CFP — 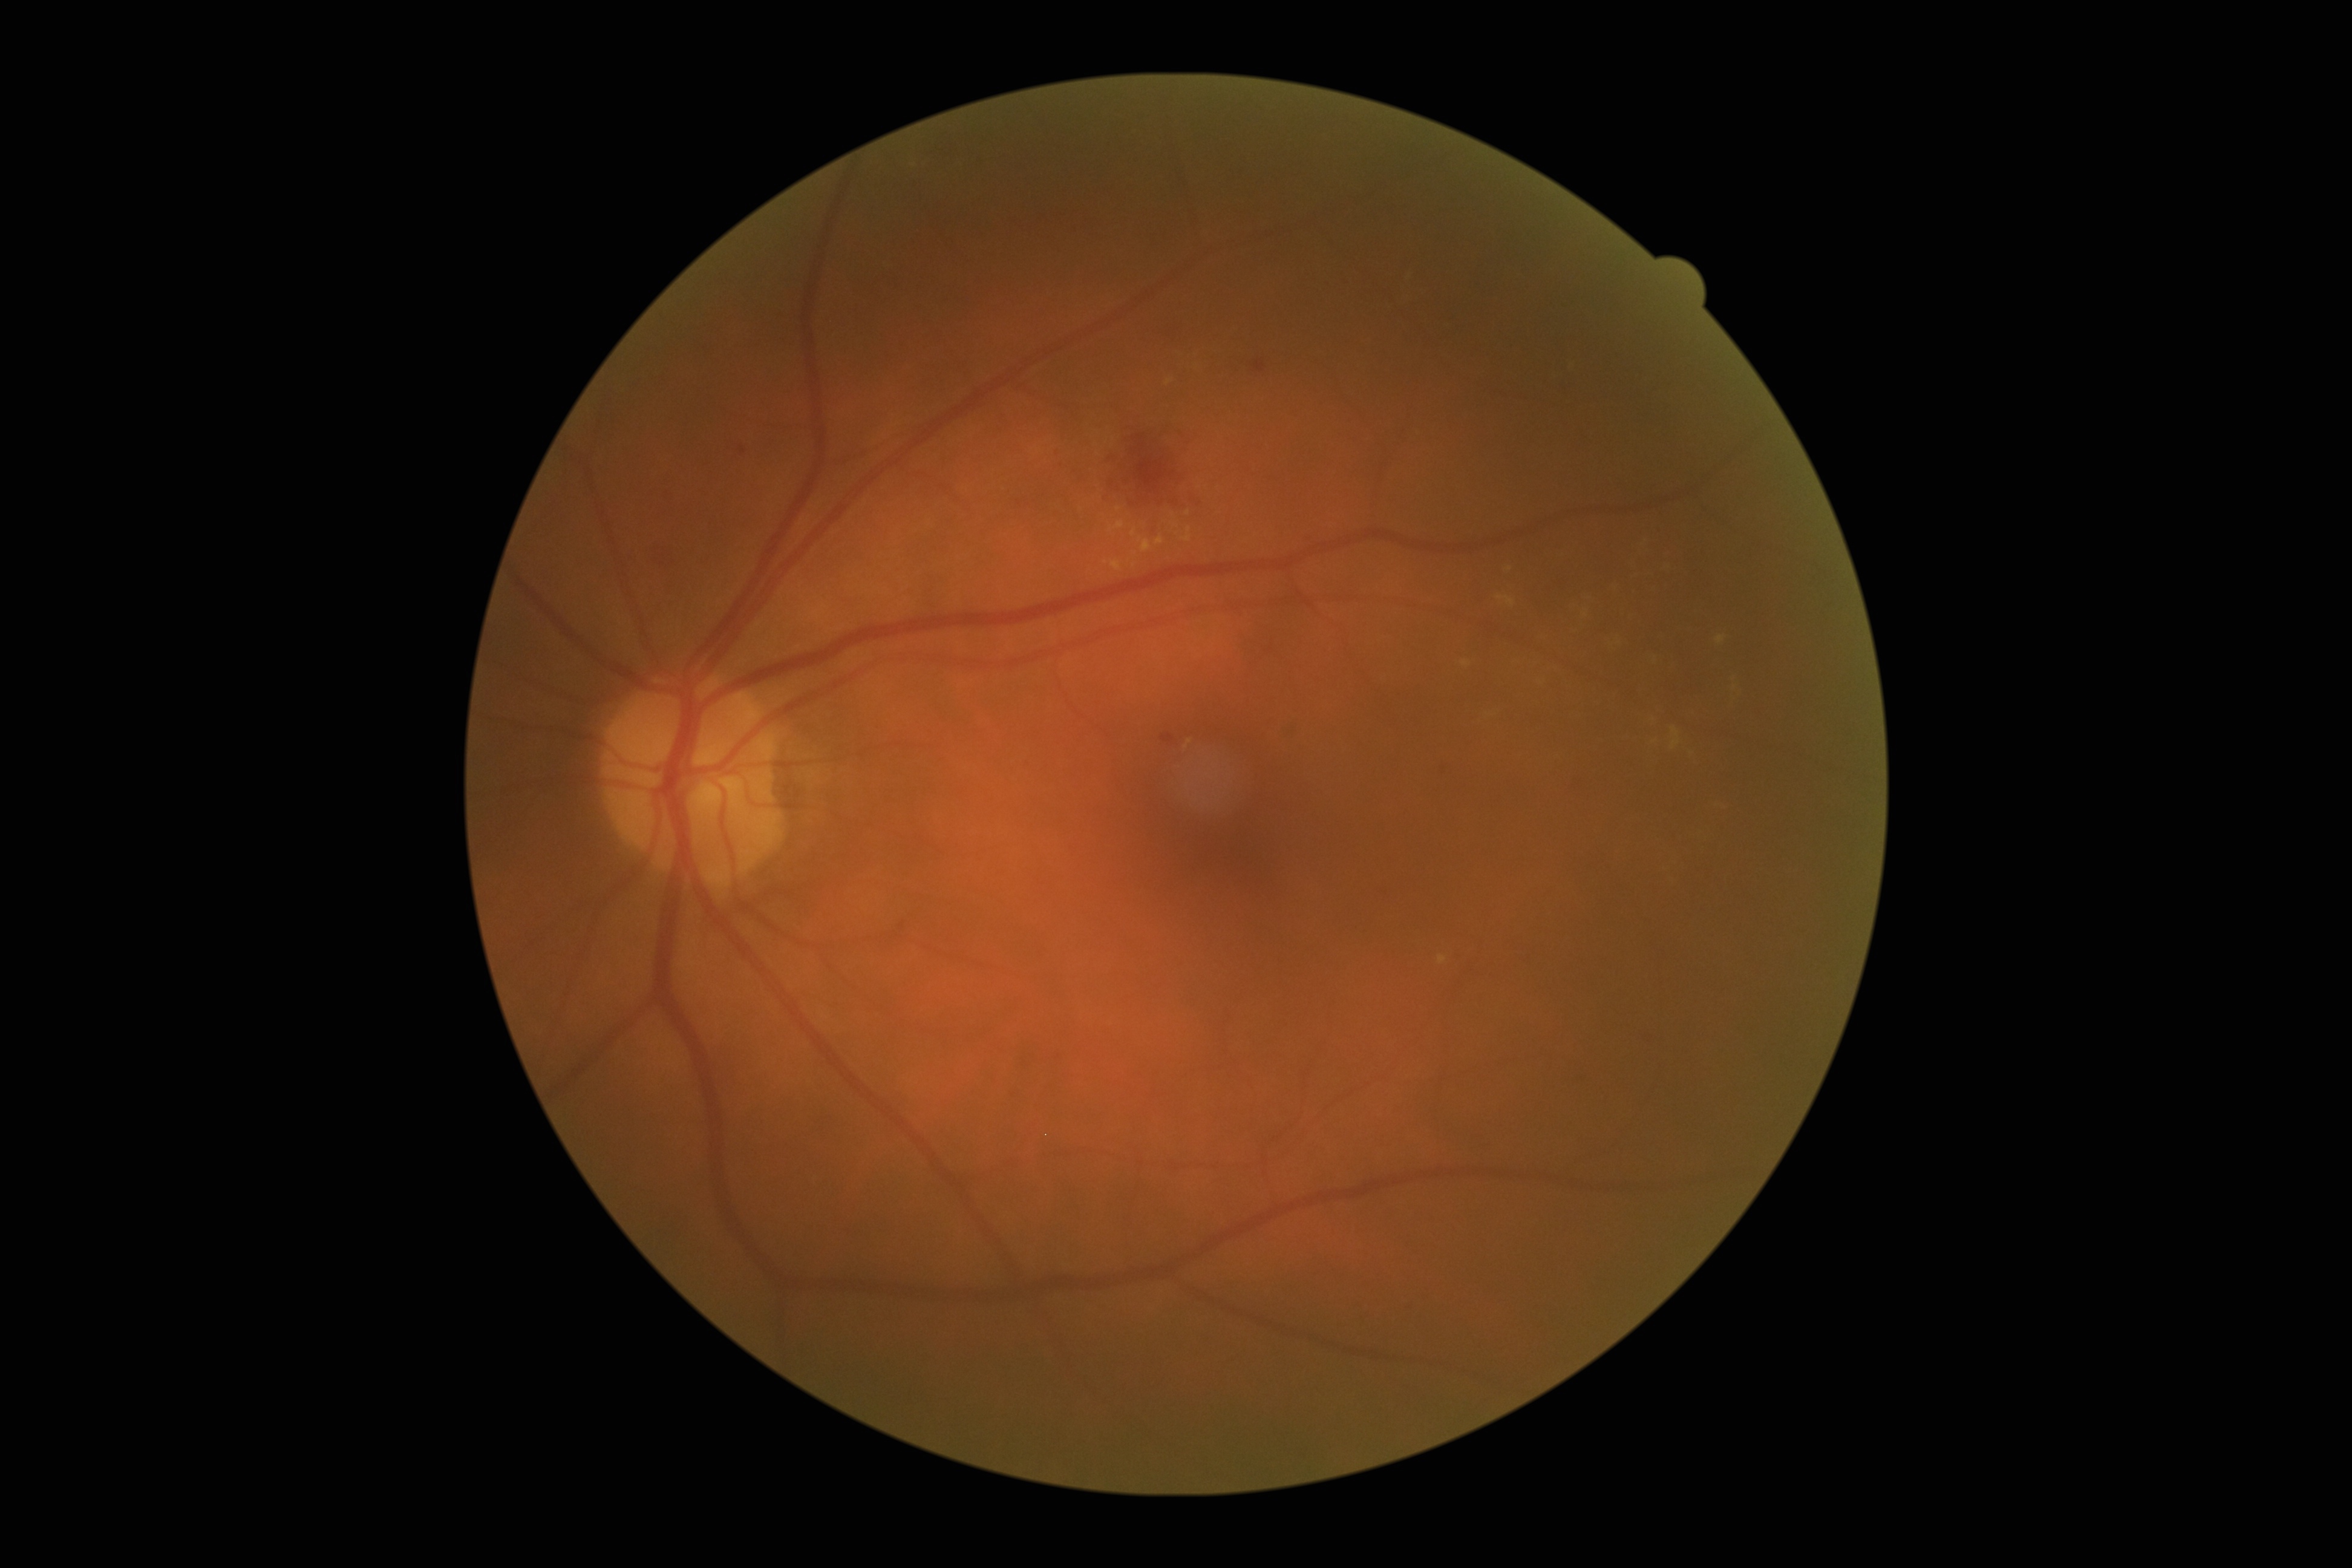

DR is 2. EXs are present, including at (1166, 379, 1174, 387), (1108, 503, 1196, 555), (1496, 595, 1515, 608), (1486, 537, 1754, 730), (1392, 266, 1437, 307), (1184, 740, 1192, 748), (1439, 954, 1448, 964), (1461, 660, 1471, 666), (1707, 798, 1742, 811), (1563, 356, 1579, 376). Small EXs near Point(1509, 569). HEs are present, including at (645, 539, 683, 570), (995, 414, 1011, 433), (734, 442, 751, 458), (1429, 754, 1456, 785), (1282, 720, 1301, 742), (1400, 1299, 1417, 1312), (1161, 733, 1175, 746), (1244, 354, 1276, 378), (1295, 531, 1315, 545), (1097, 403, 1203, 541), (1635, 1033, 1662, 1052), (1567, 1067, 1593, 1087), (1566, 774, 1593, 795), (660, 487, 677, 506), (1468, 1132, 1495, 1155), (1052, 449, 1060, 456), (1367, 878, 1400, 909). Small HEs near Point(903, 926), Point(1060, 465). No MAs identified. No SEs identified.